RetCam wide-field infant fundus image: 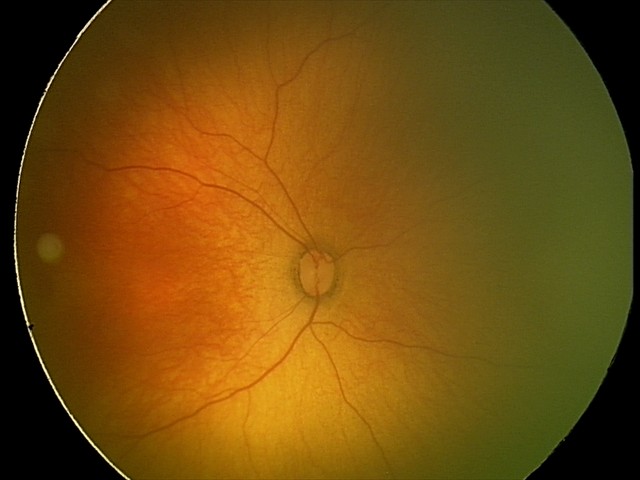
From an examination with diagnosis of ROP stage 1. Plus disease absent.